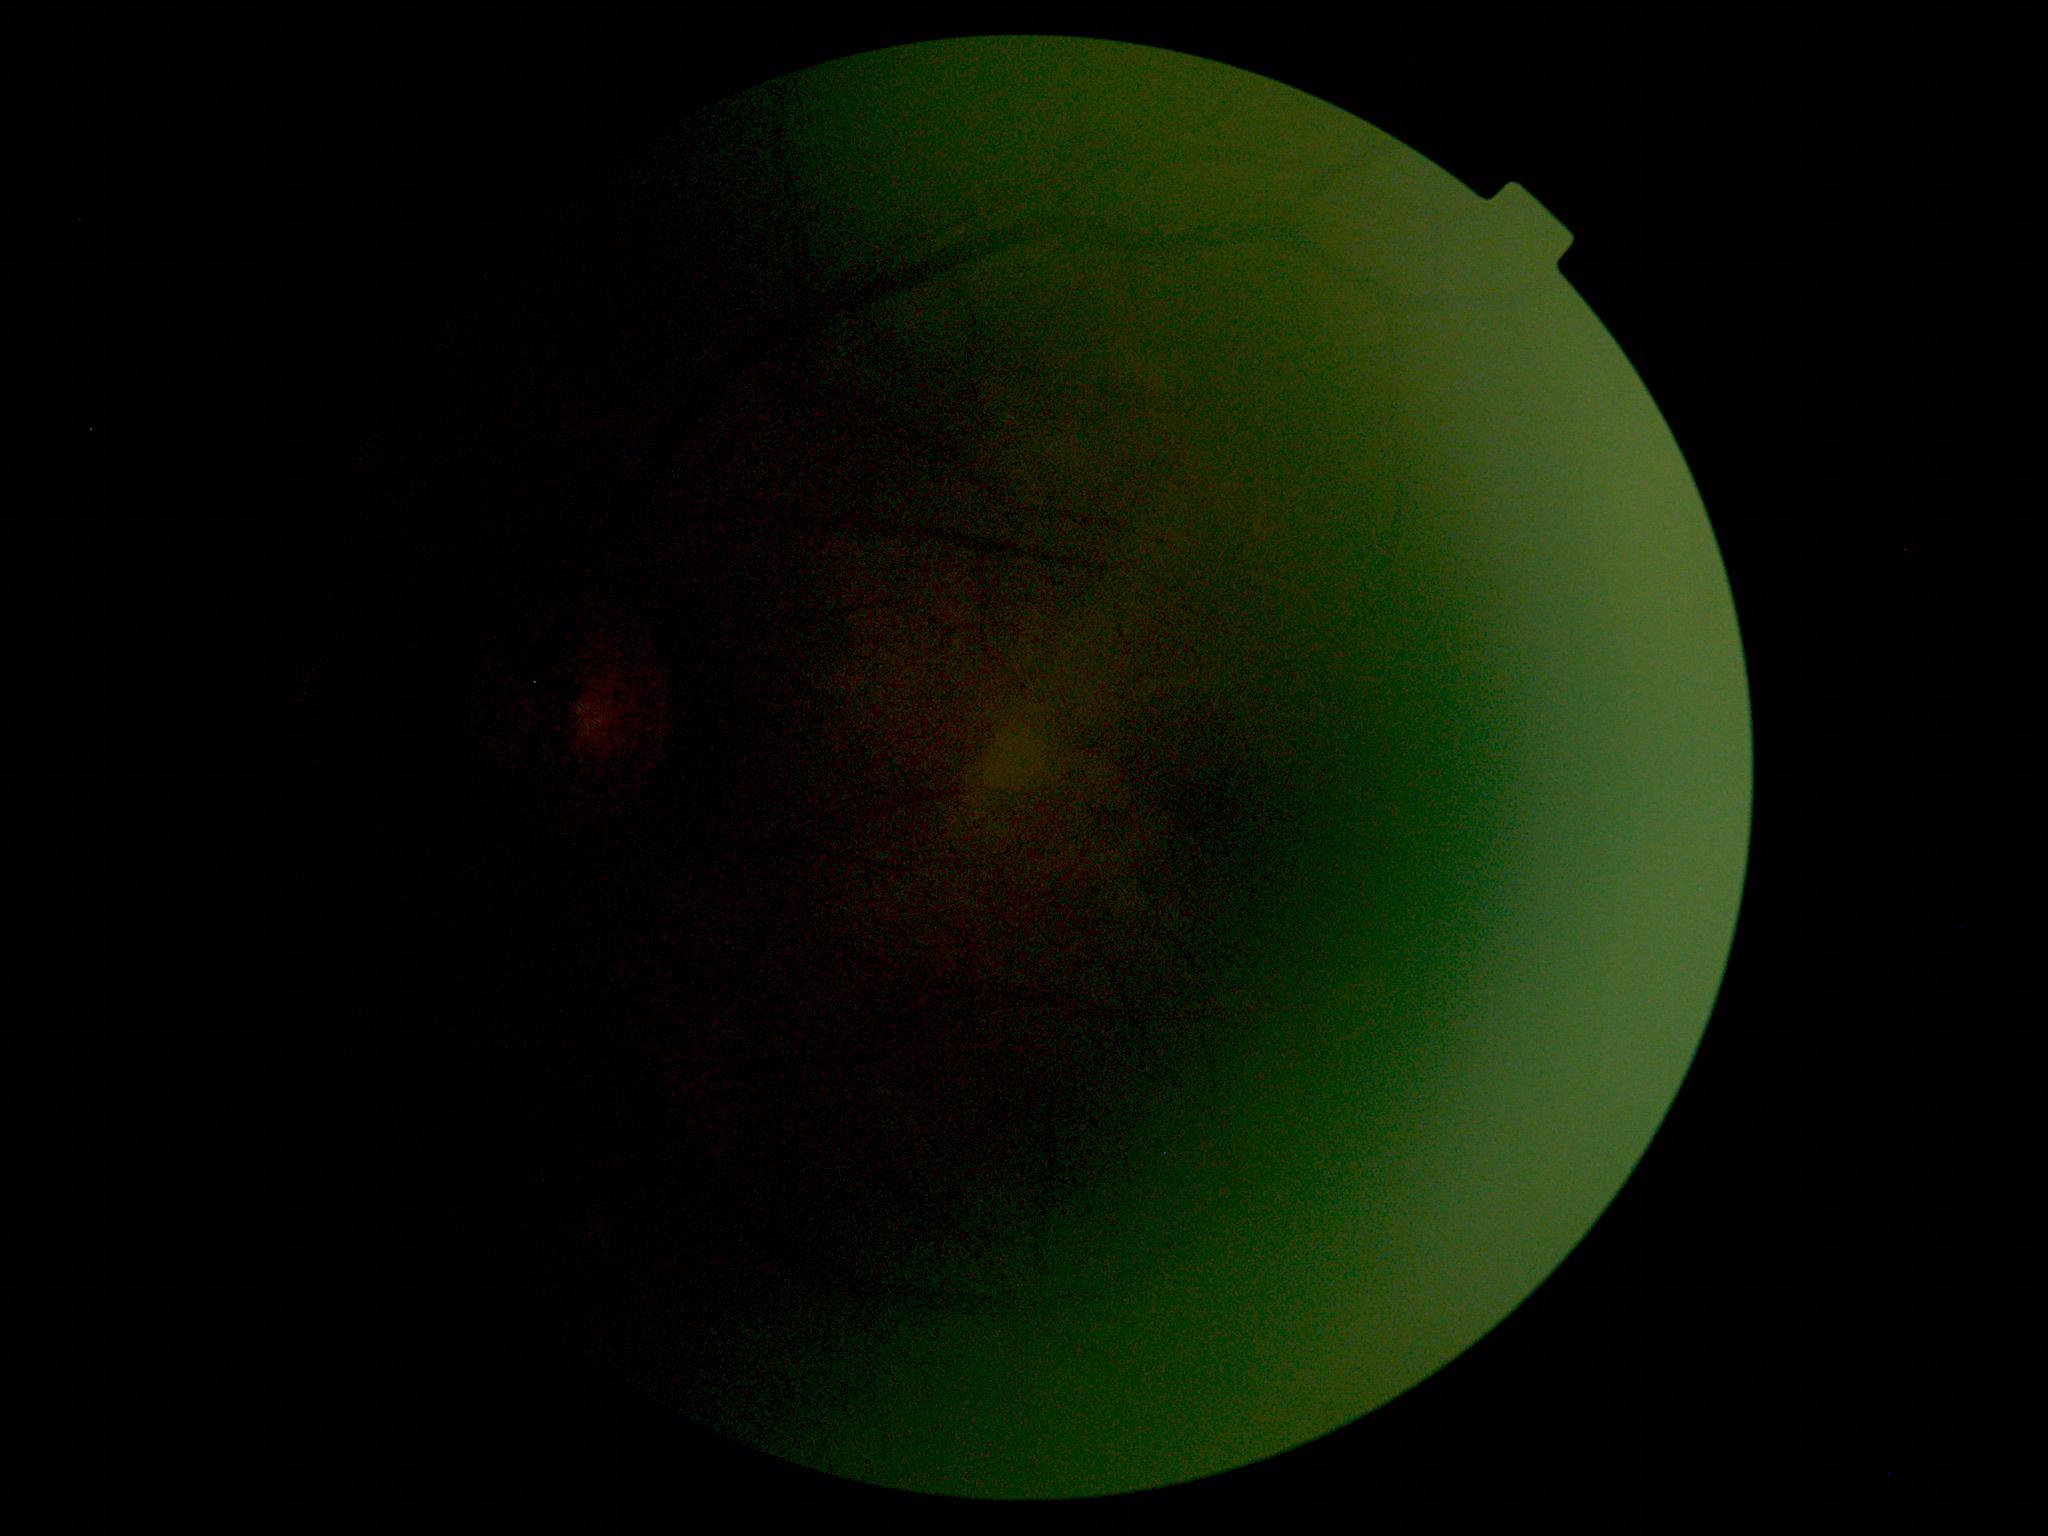 Quality too poor to assess for DR.
Retinopathy is ungradable due to poor image quality.